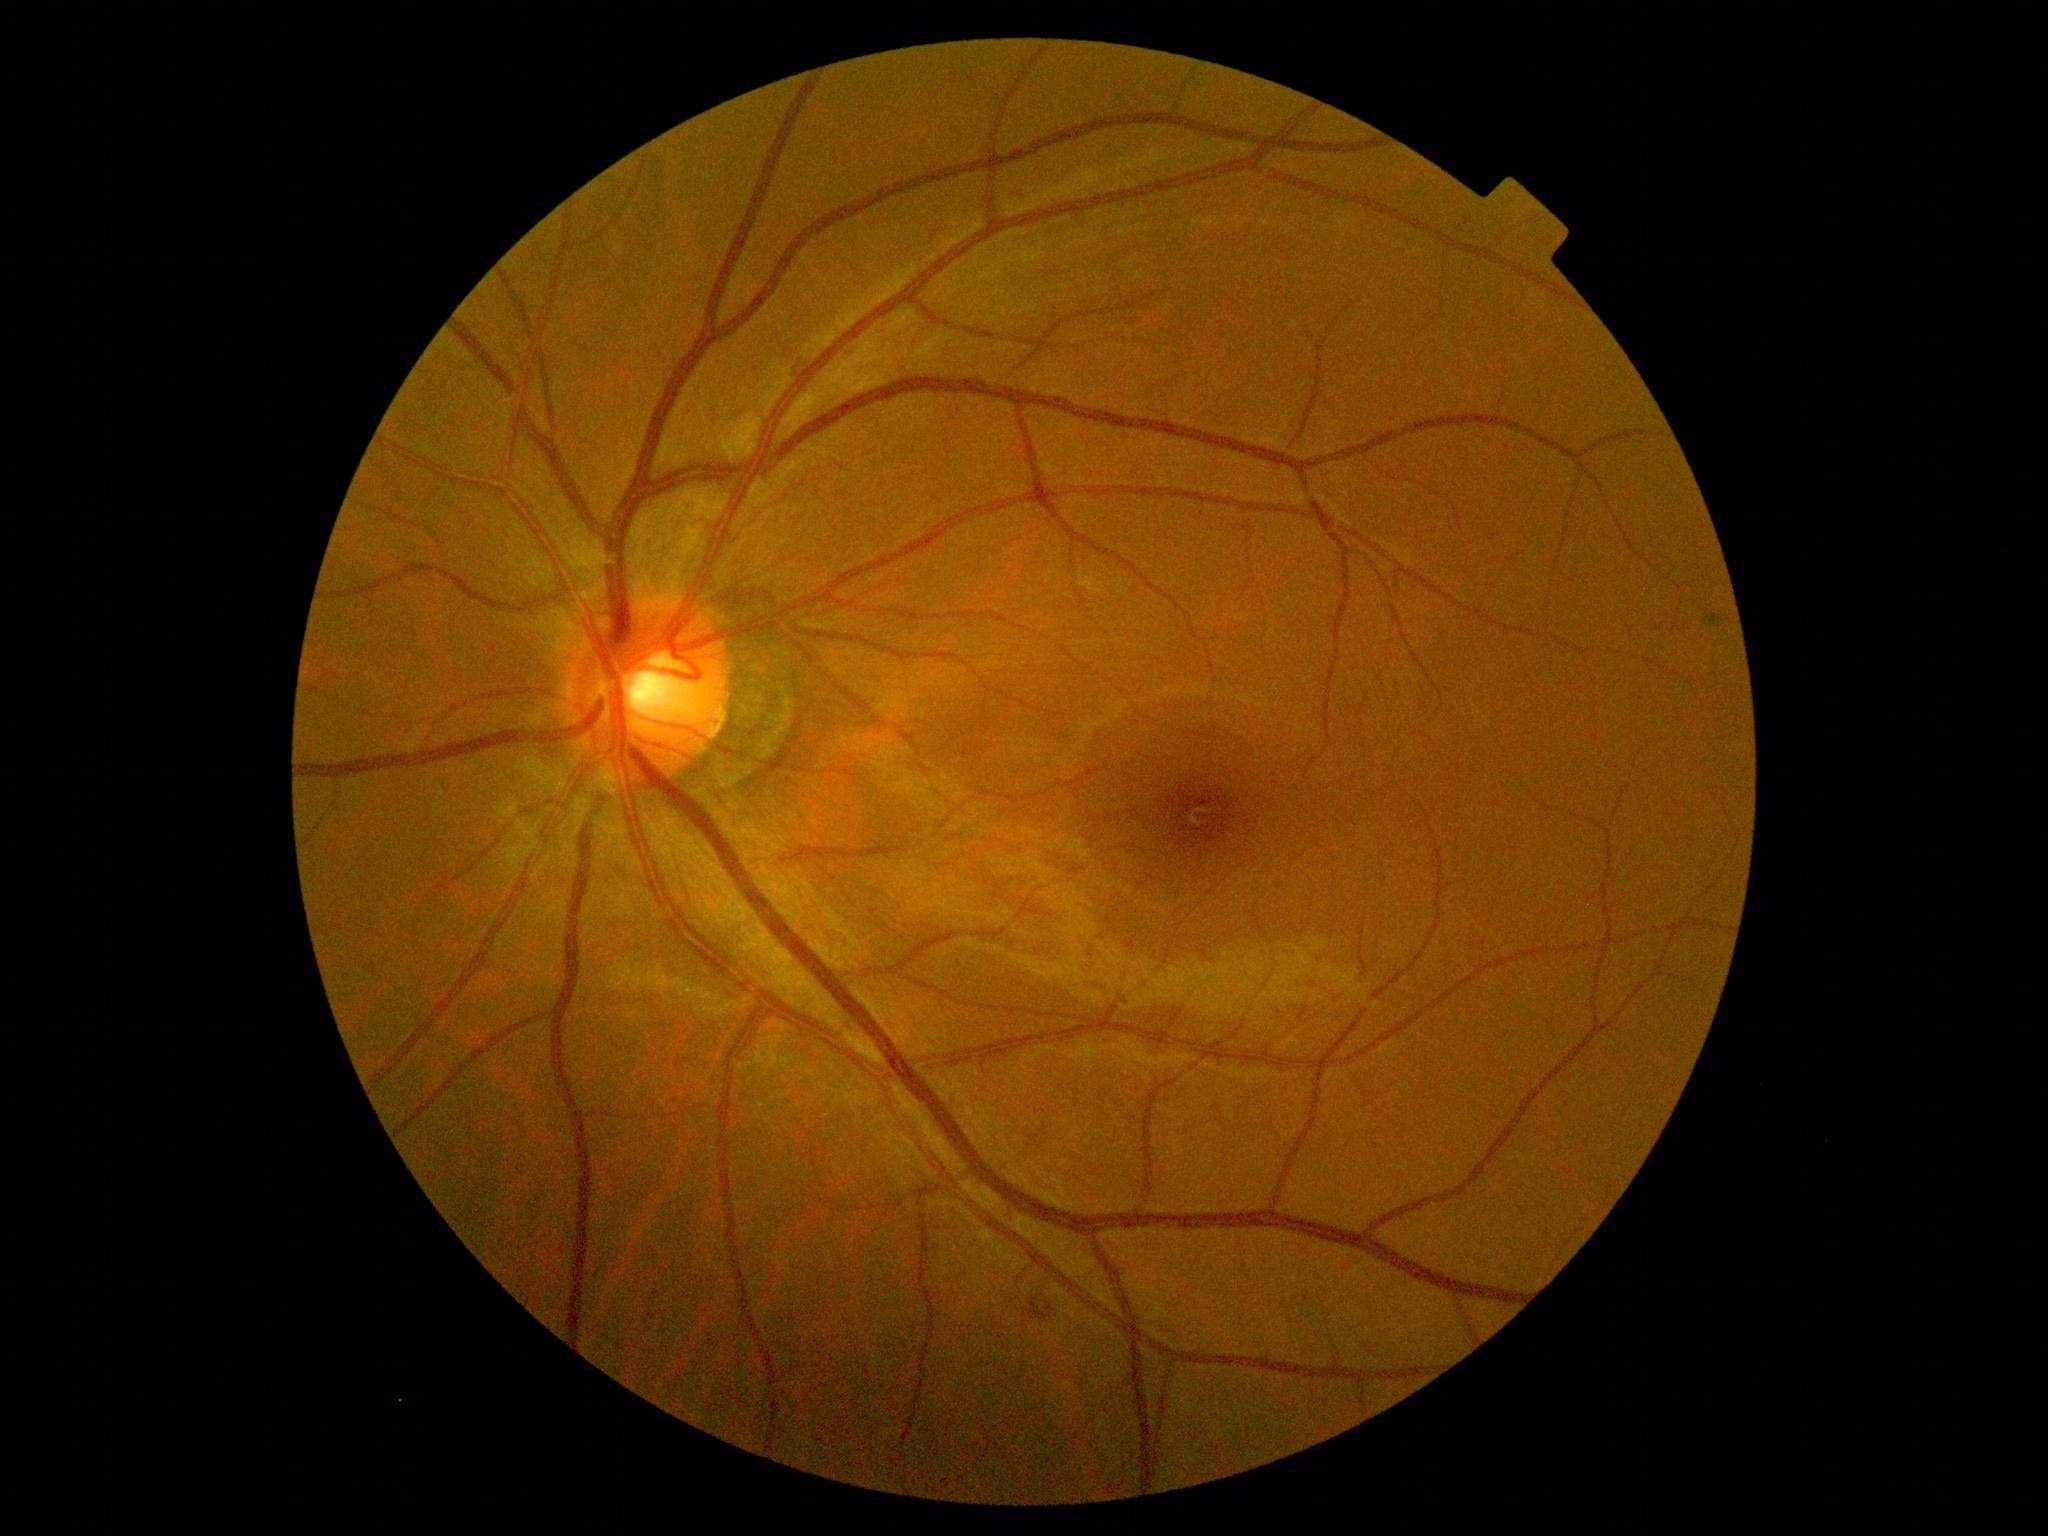 Diabetic retinopathy (DR): moderate NPDR (grade 2).